Modified Davis classification. Nonmydriatic. Image size 848x848. 45 degree fundus photograph. Posterior pole photograph:
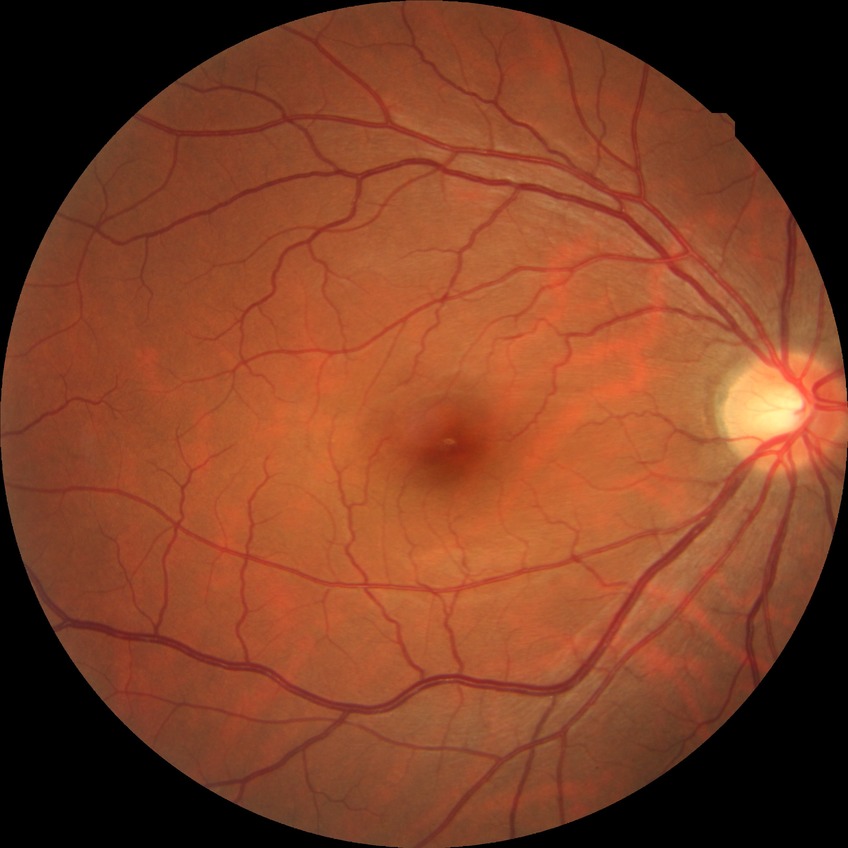

Diabetic retinopathy (DR) is no diabetic retinopathy (NDR).